CFP.
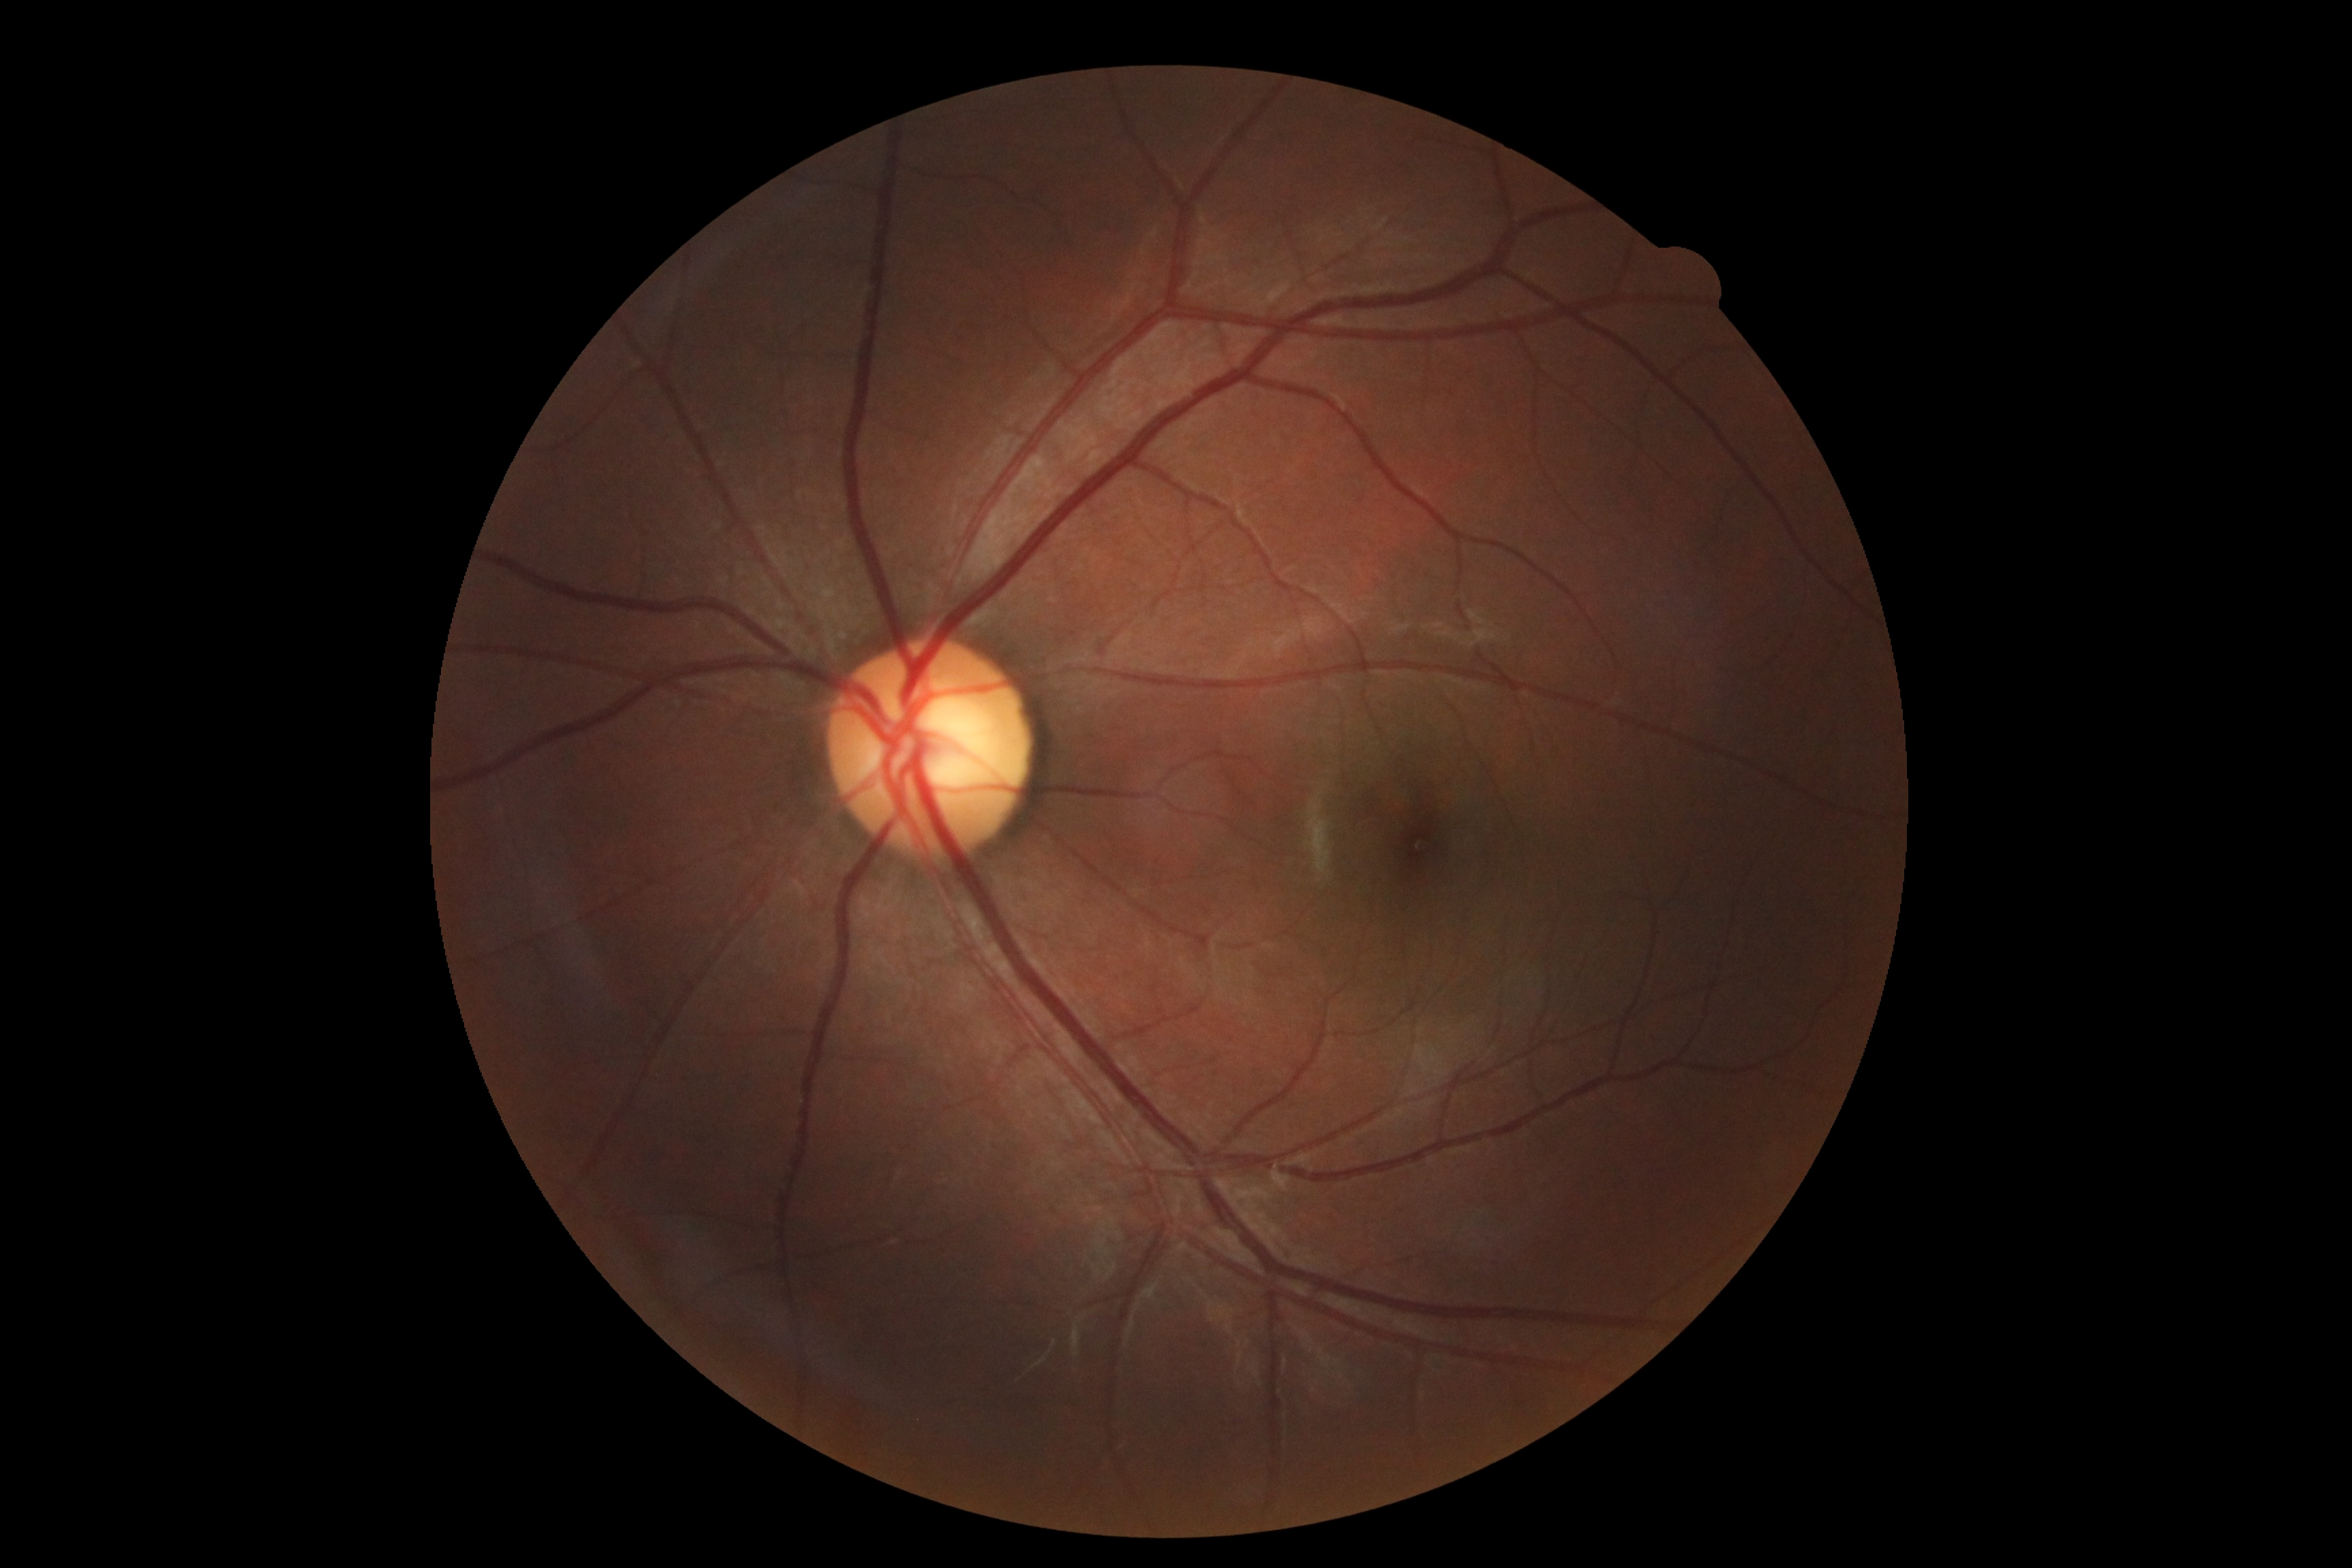 {"dr_grade": "0/4"}